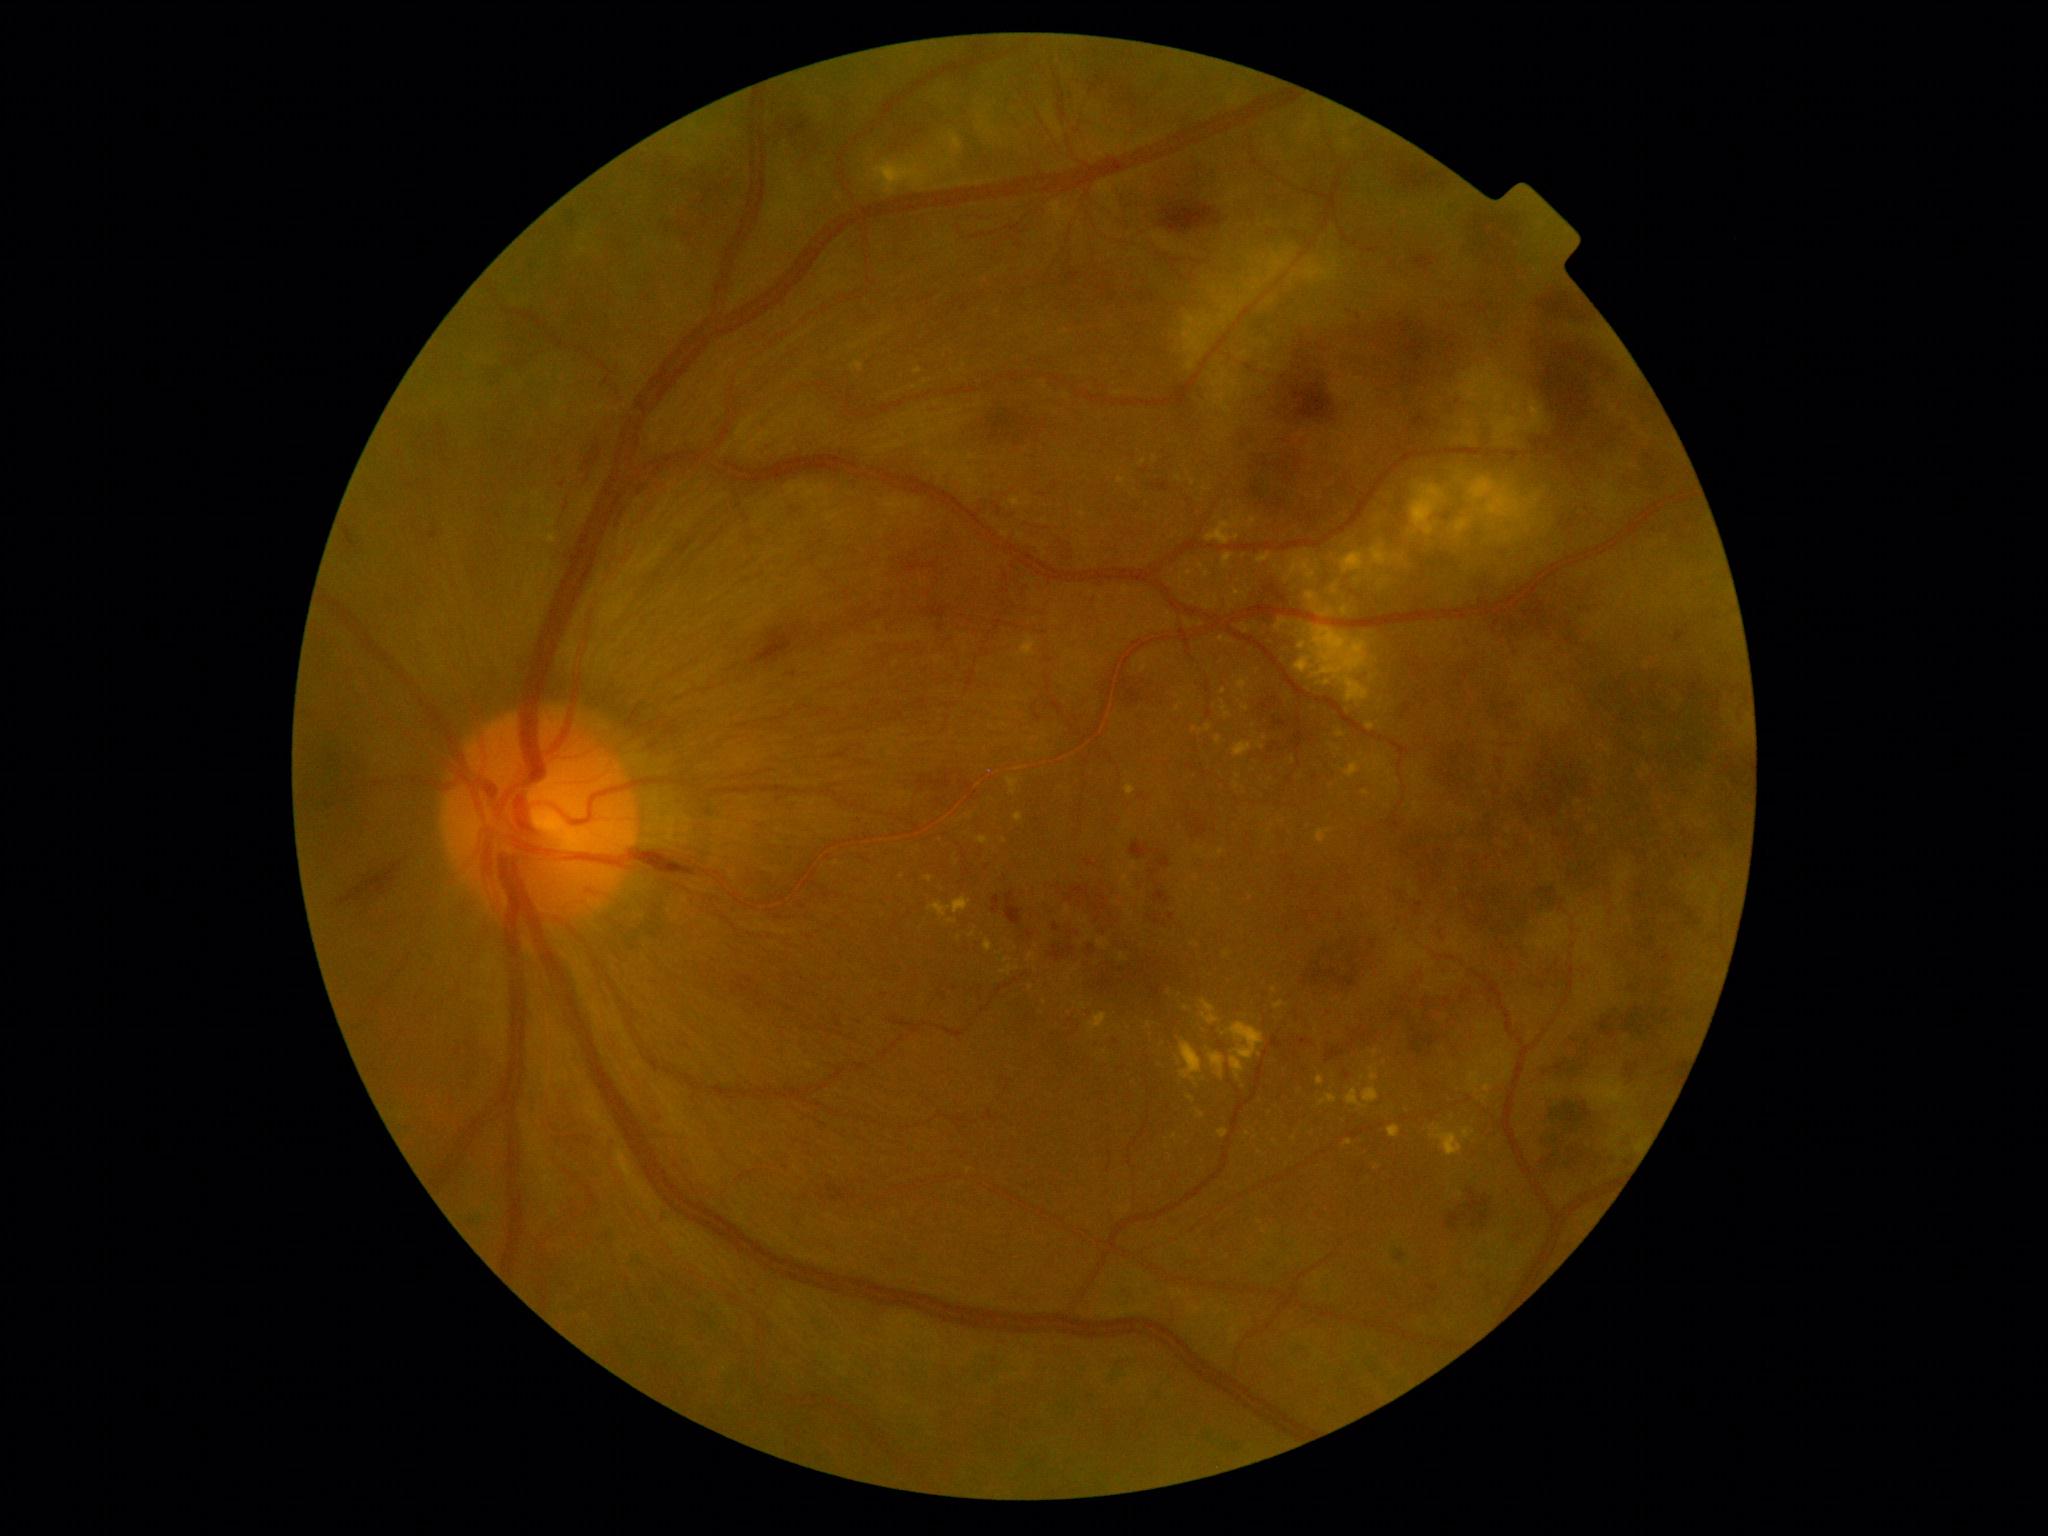

{"partial":true,"dr_grade":4,"lesions":{"ex":[[1220,700,1231,720],[1431,1126,1463,1157],[1218,1128,1228,1138],[1198,1111,1206,1118],[1122,875,1133,889],[1088,1012,1108,1032],[1028,952,1035,962],[1016,767,1024,772],[984,939,994,952]],"ex_small_approx":[[1155,459],[1232,607],[1030,750],[1196,946],[1363,1077],[1224,692],[1068,911],[903,877]]}}